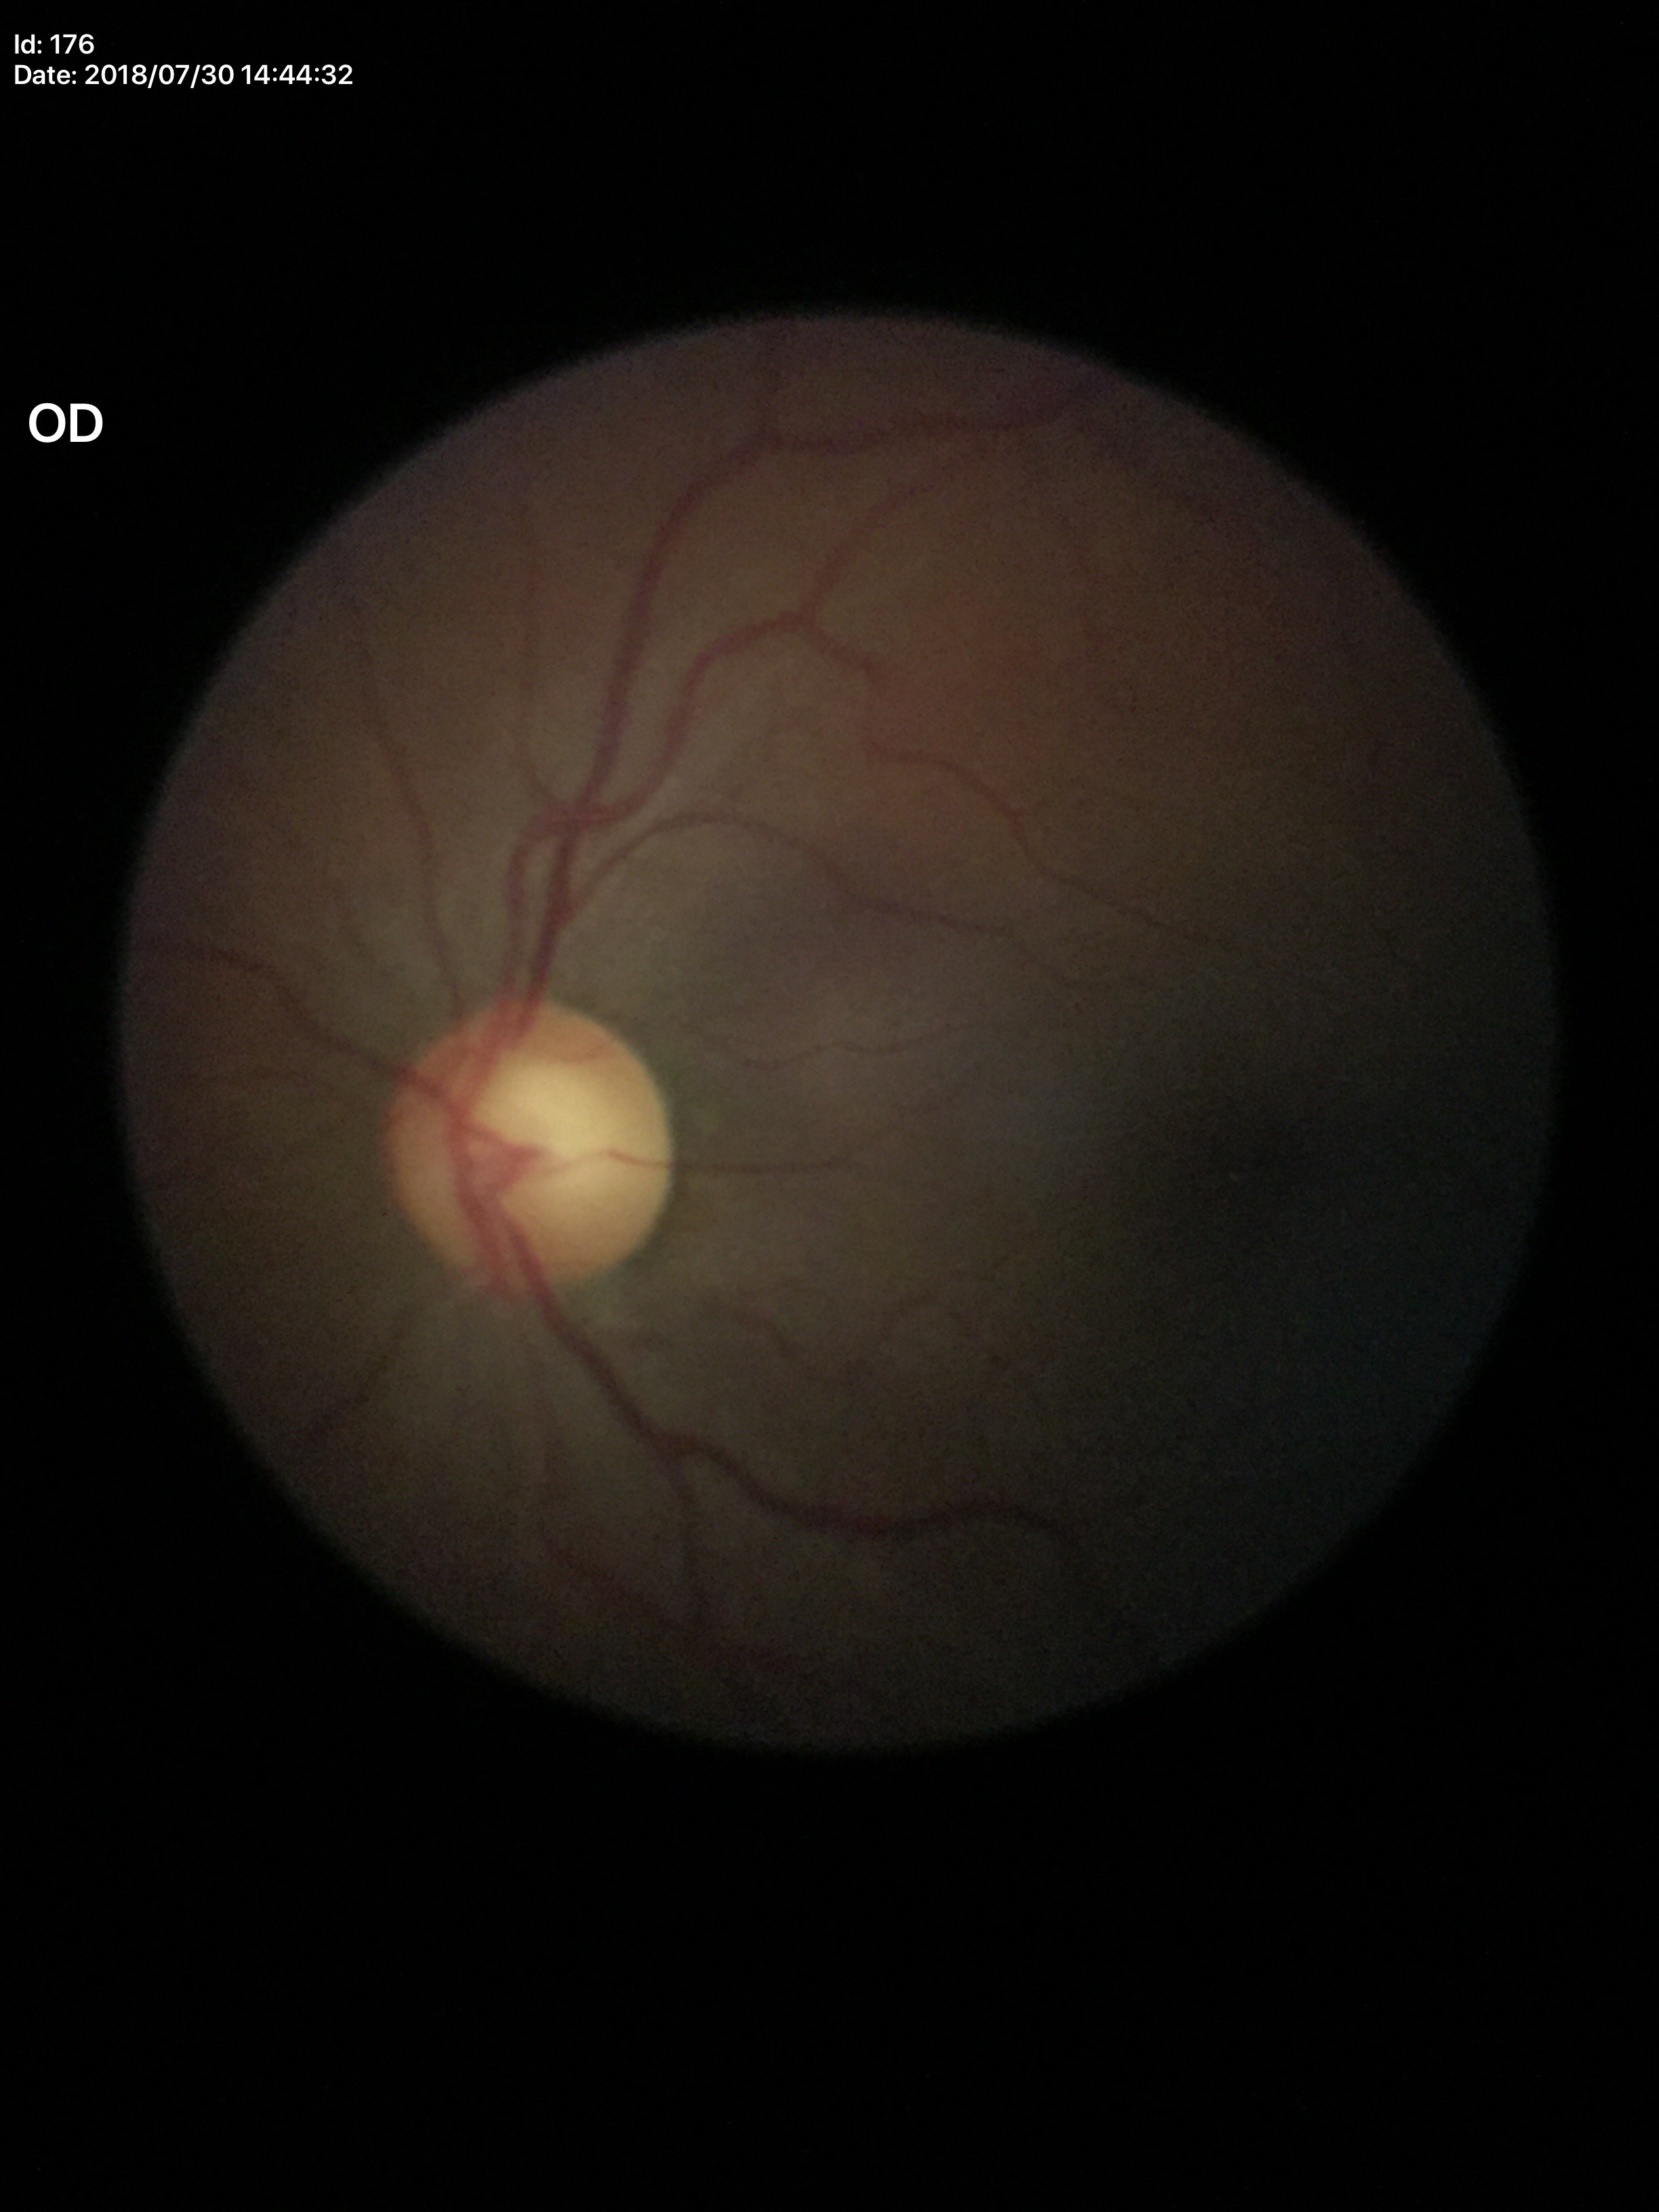

Glaucoma screening: suspicious findings.
Vertical CDR is 0.62.